FOV: 45 degrees · 2352 by 1568 pixels · color fundus photograph — 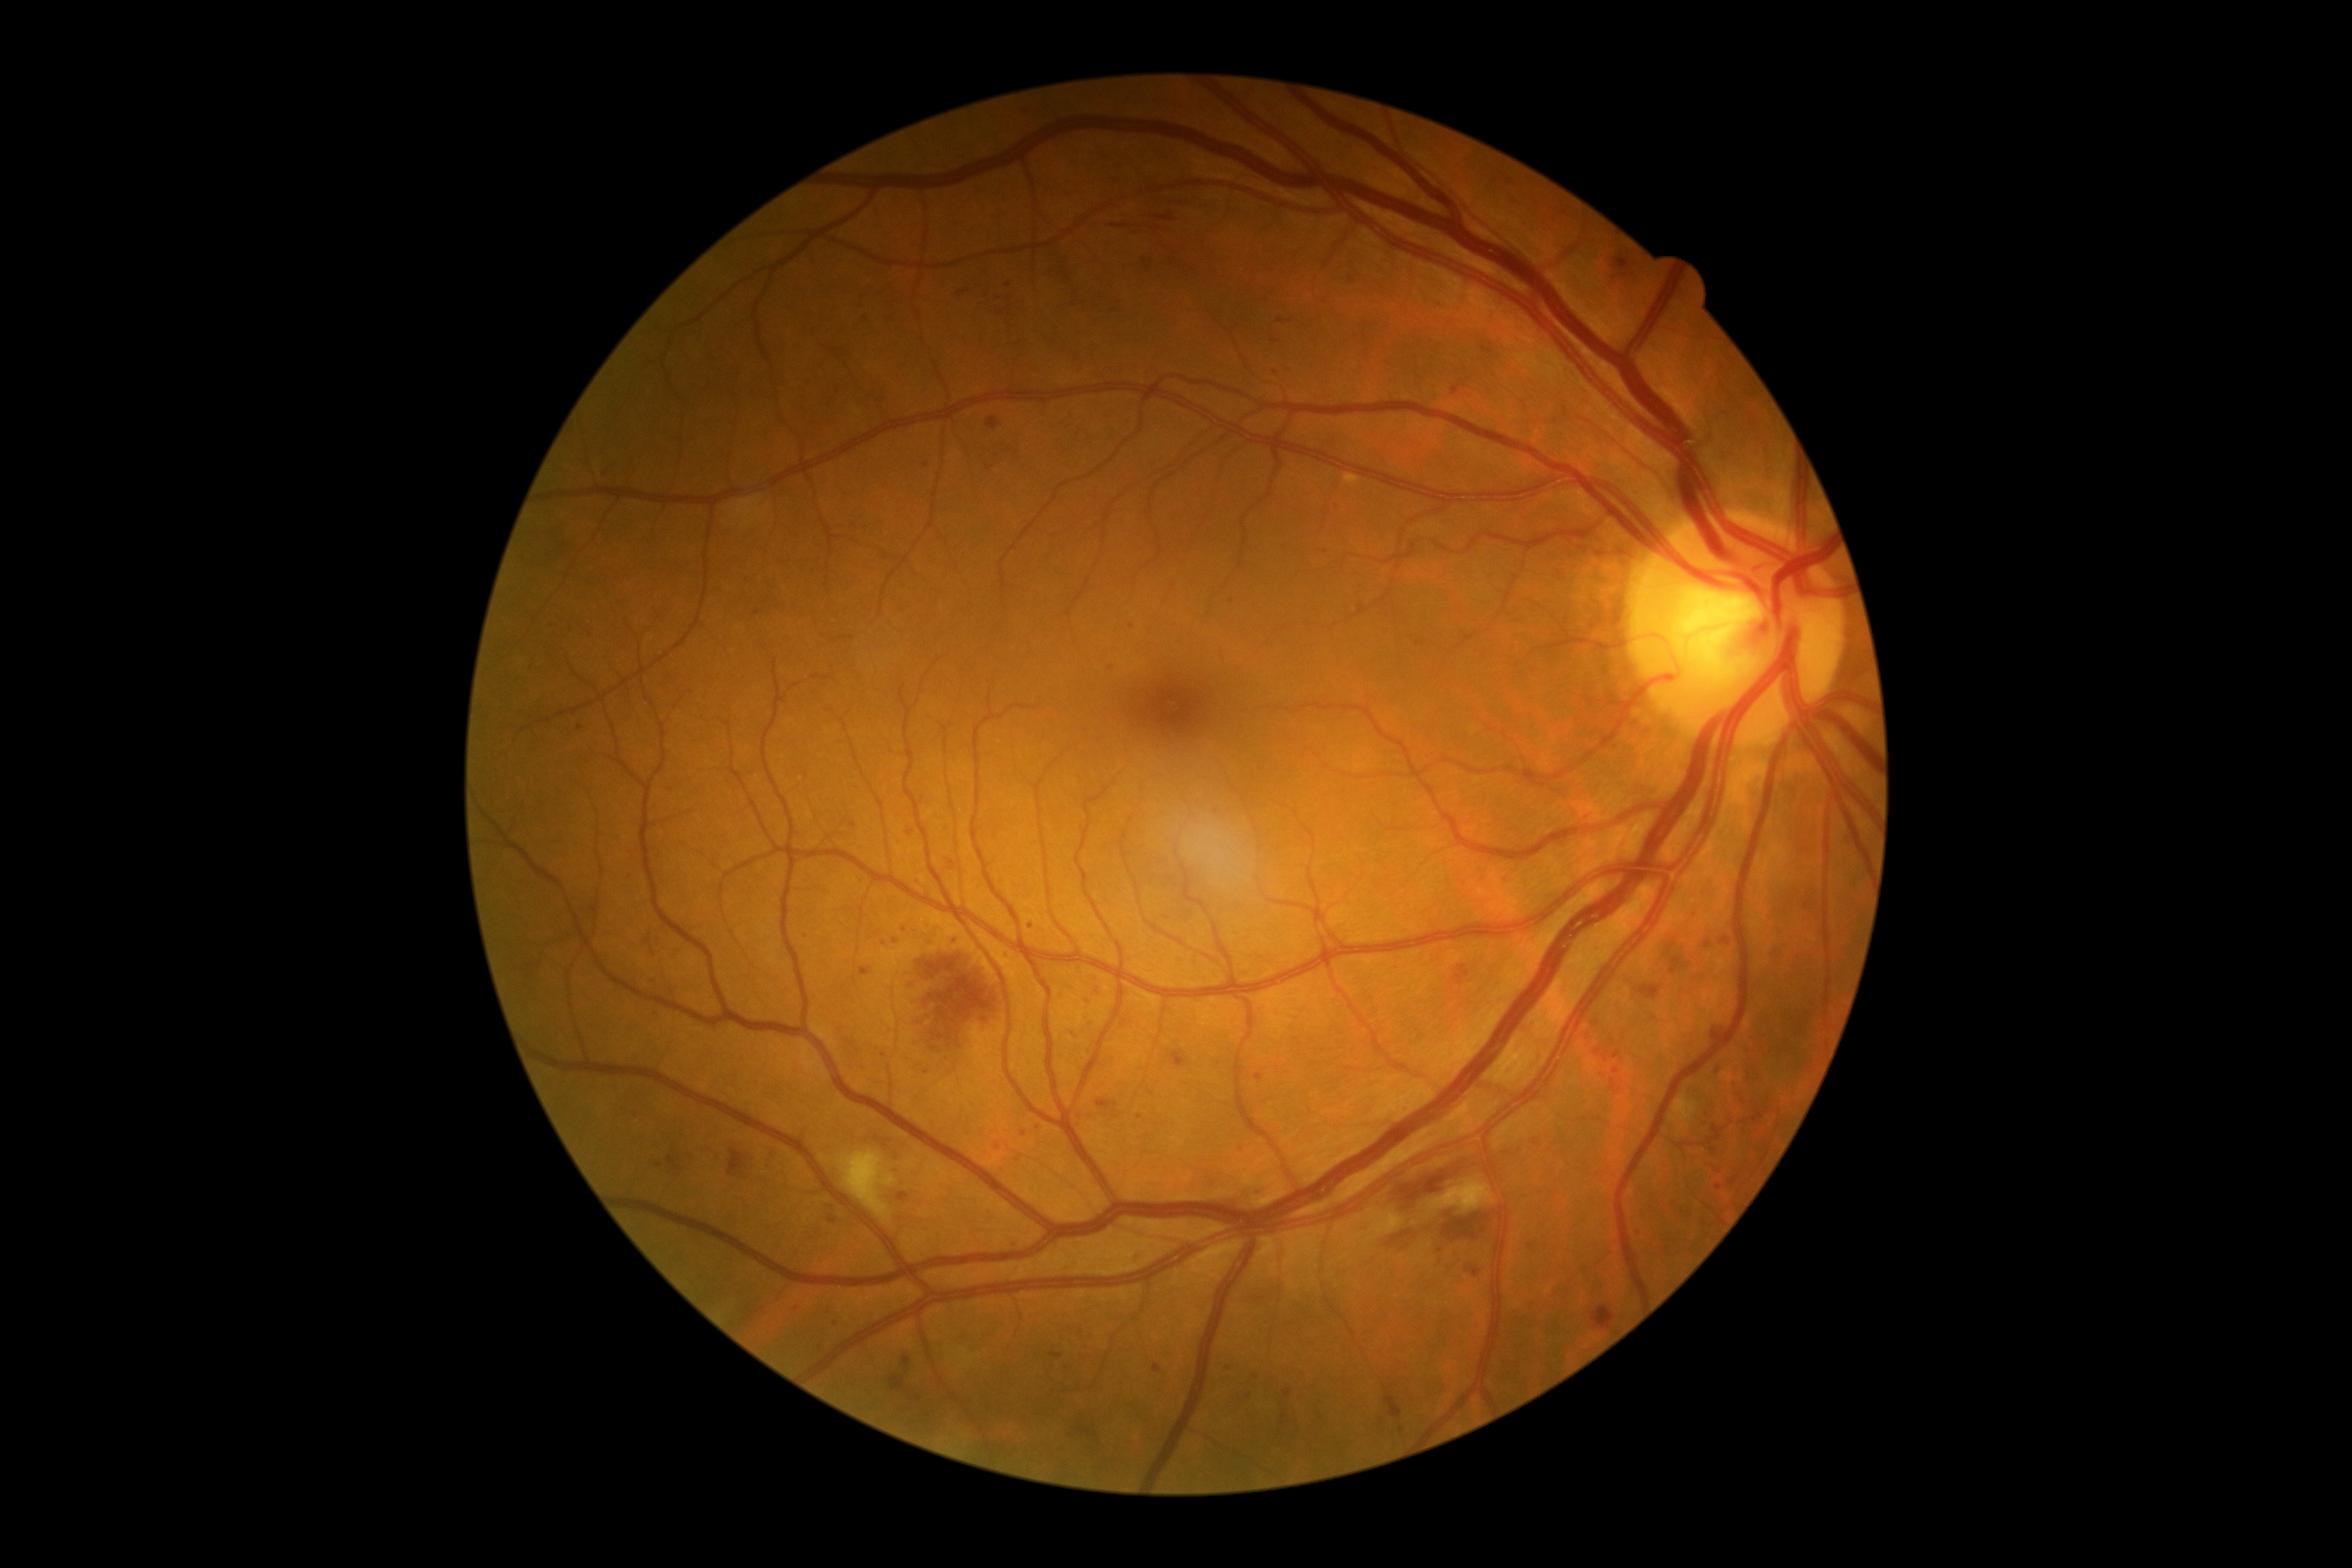

The retinopathy is classified as non-proliferative diabetic retinopathy. Diabetic retinopathy: grade 2 (moderate NPDR).